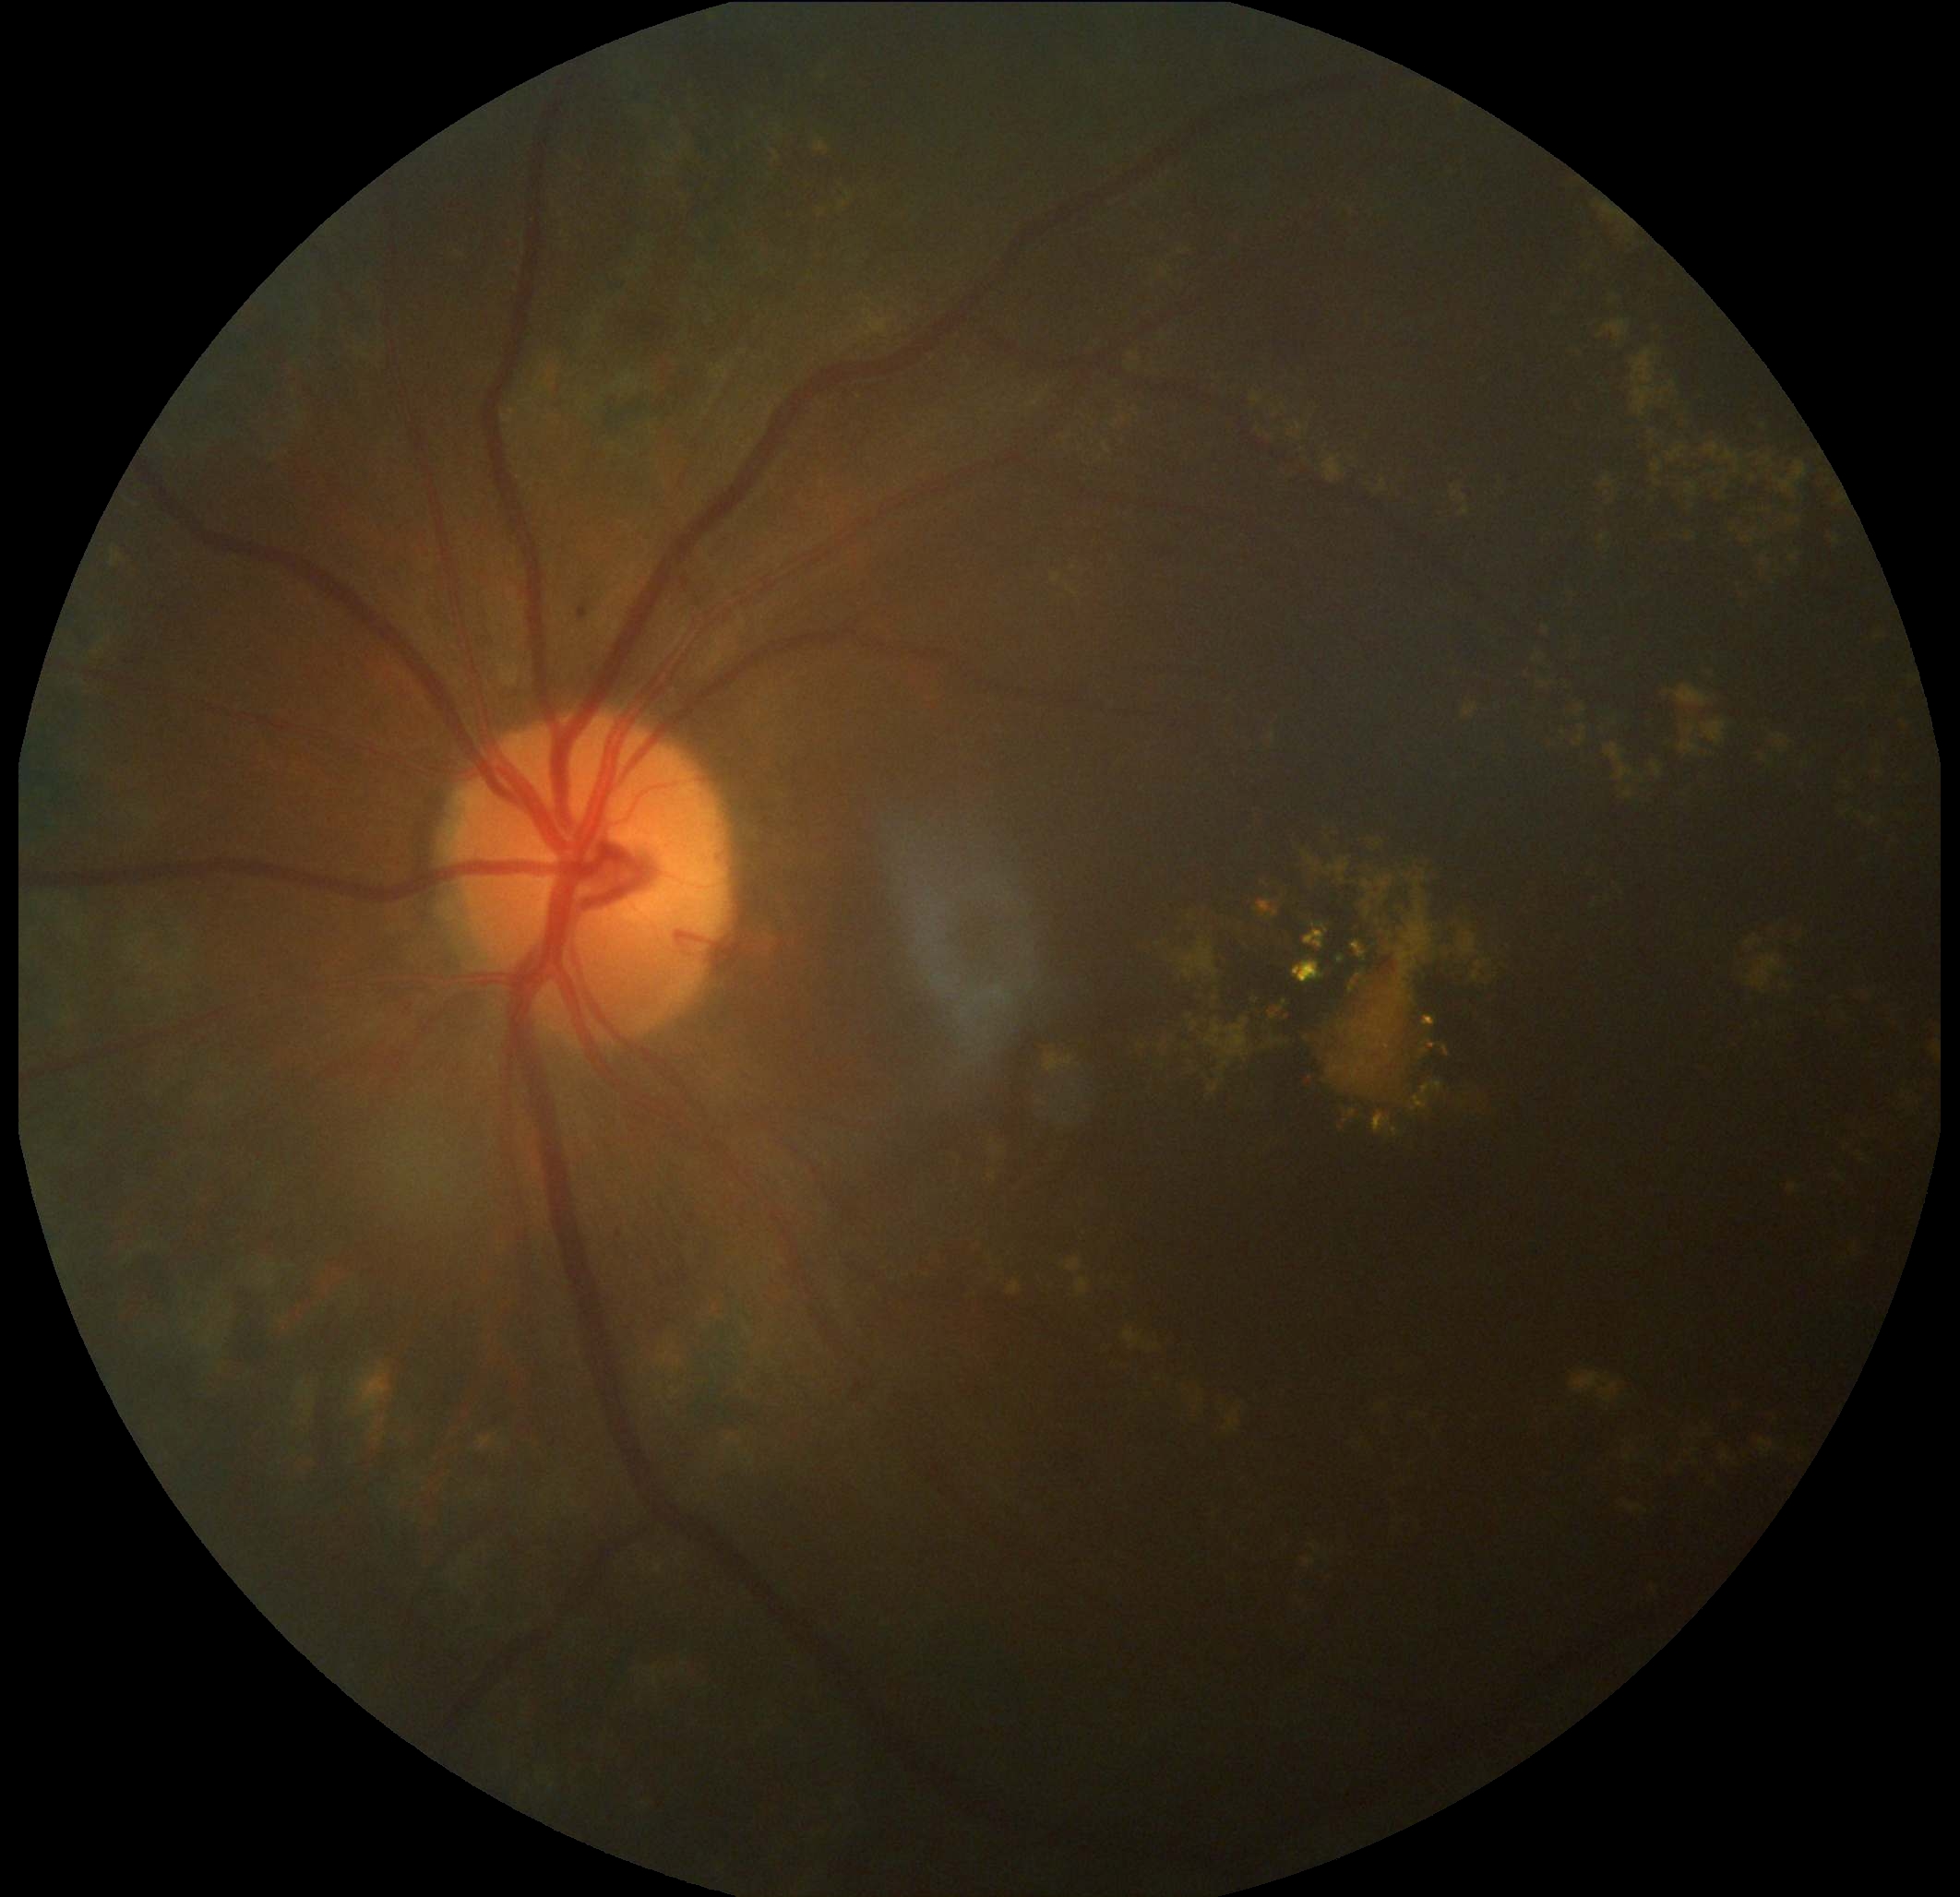

DR grade: moderate NPDR (2).